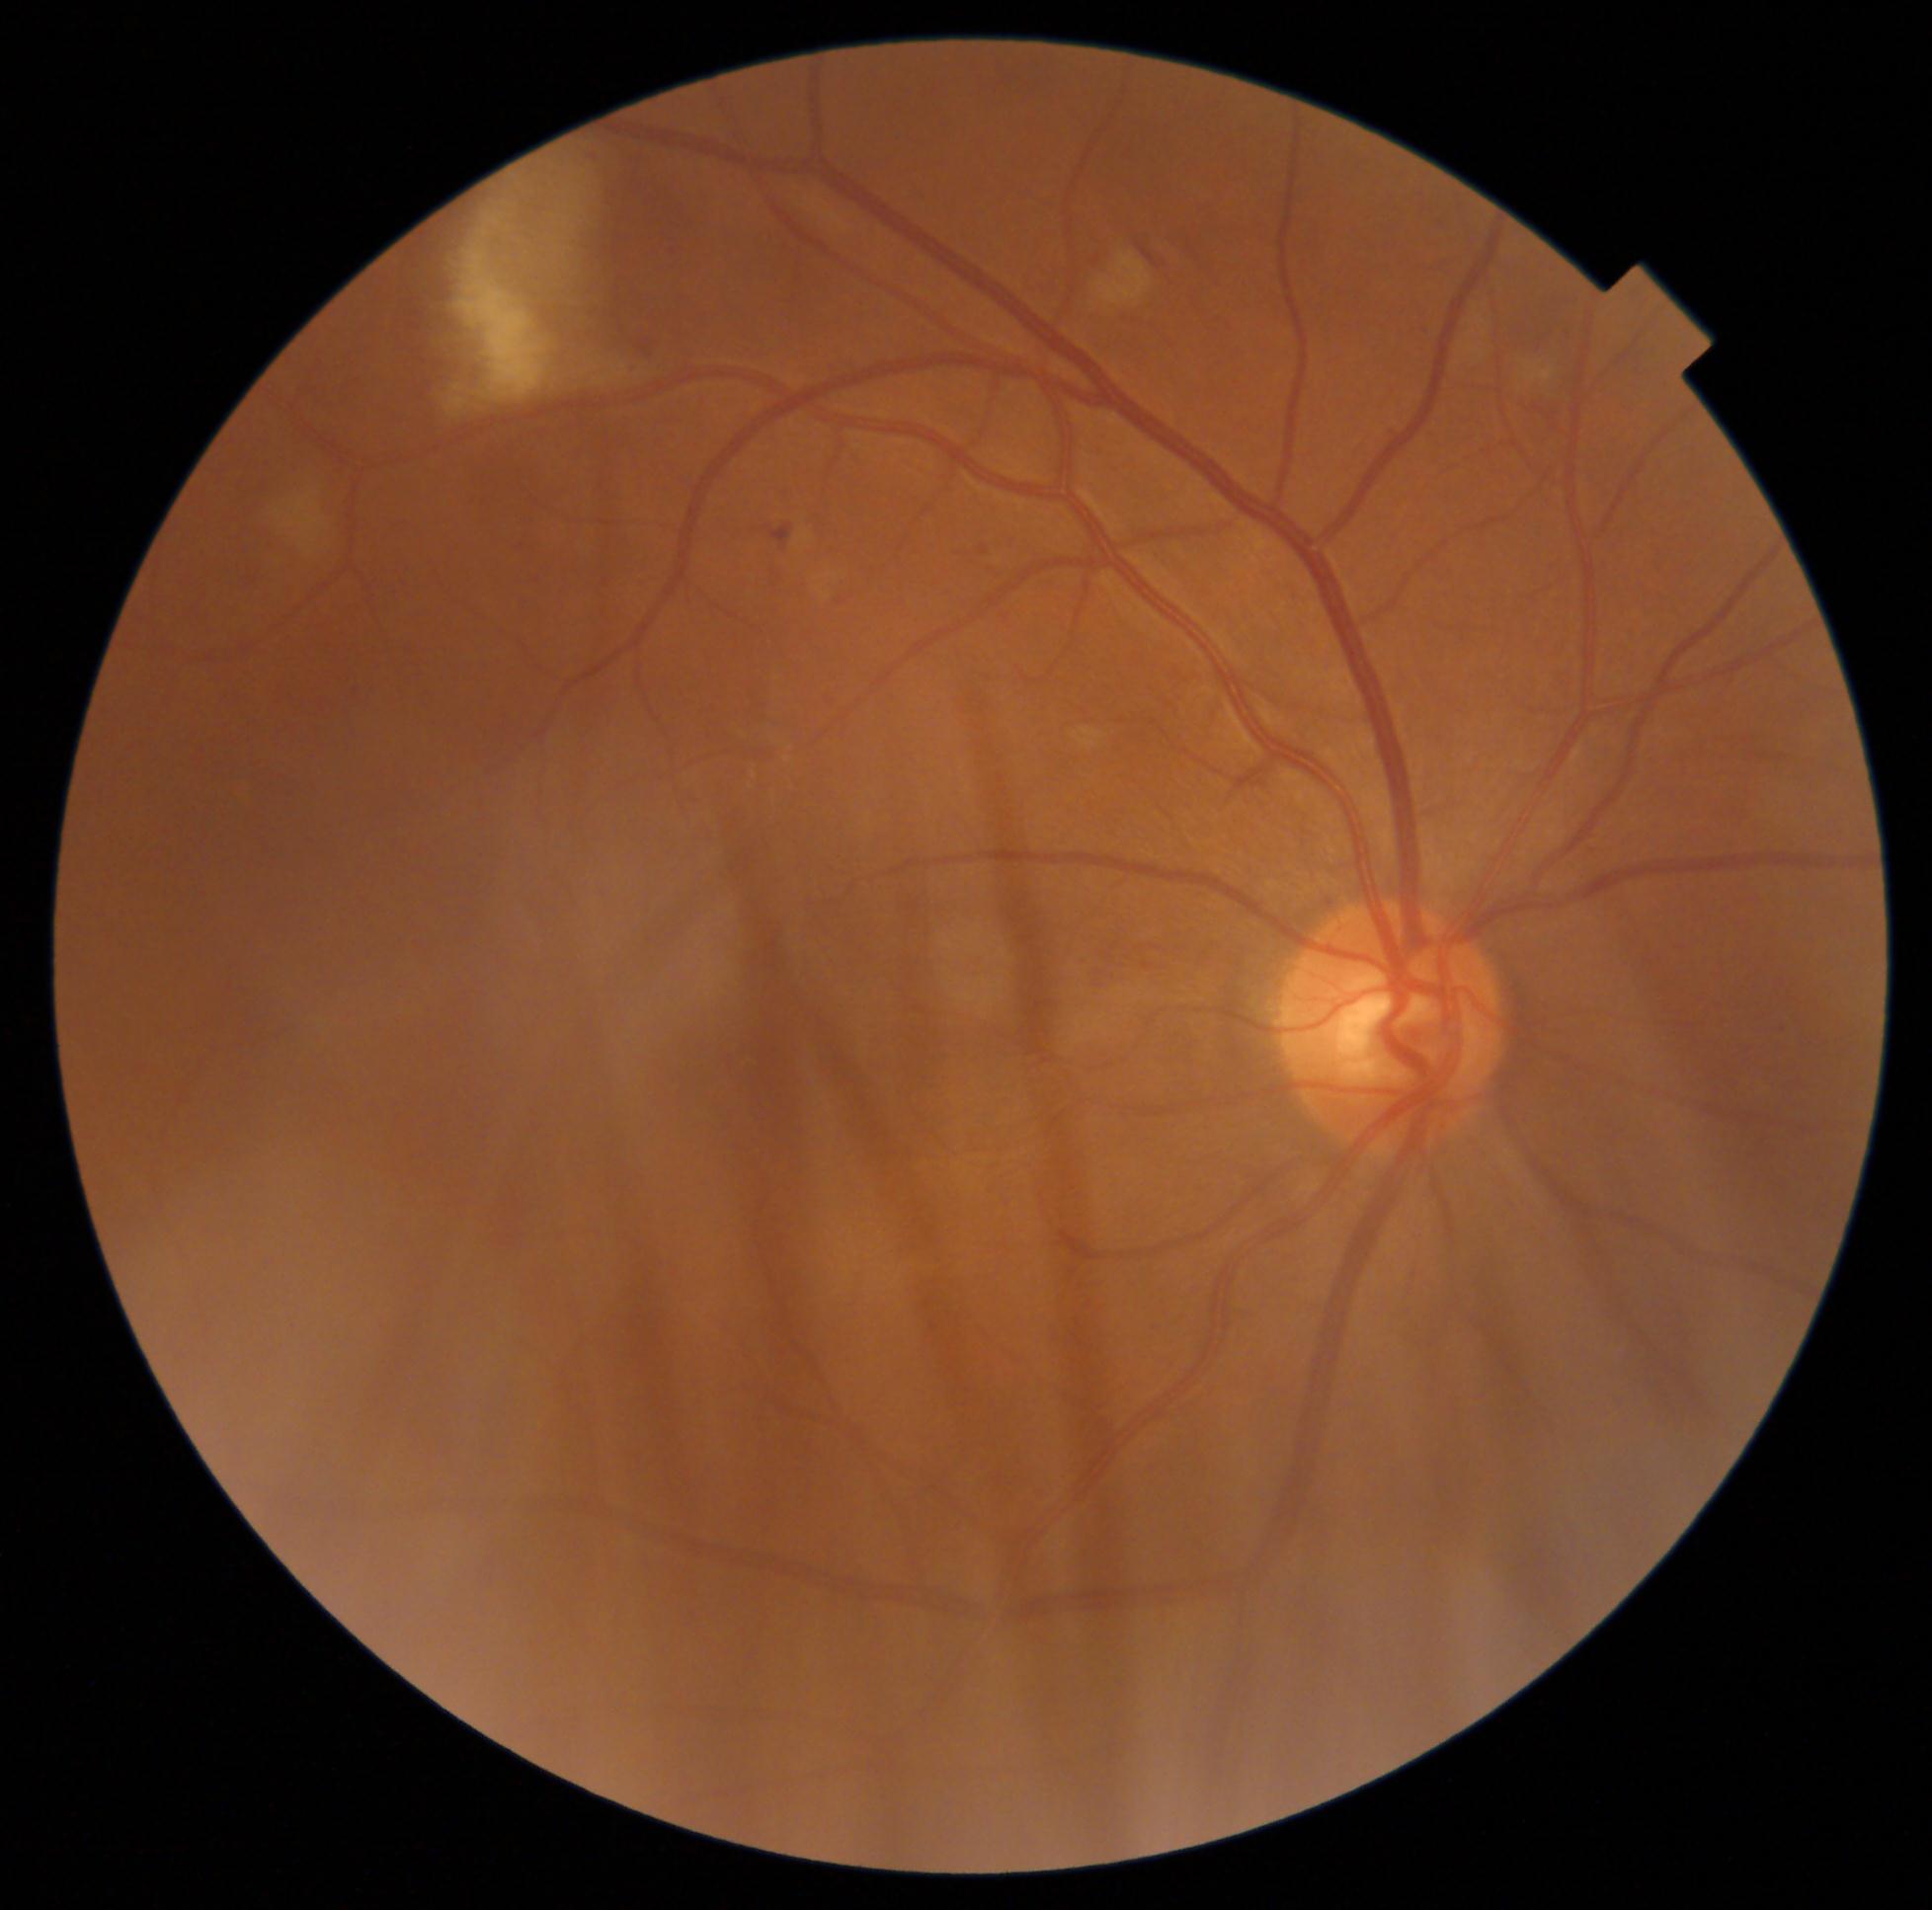

DR class: non-proliferative diabetic retinopathy. Retinopathy grade is 2 (moderate NPDR).